512 by 512 pixels. Color fundus photograph — 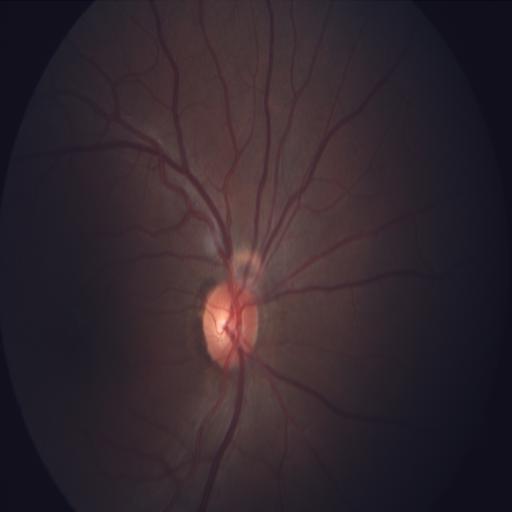 Findings consistent with media haze (MH).